45° field of view. Fundus photo — 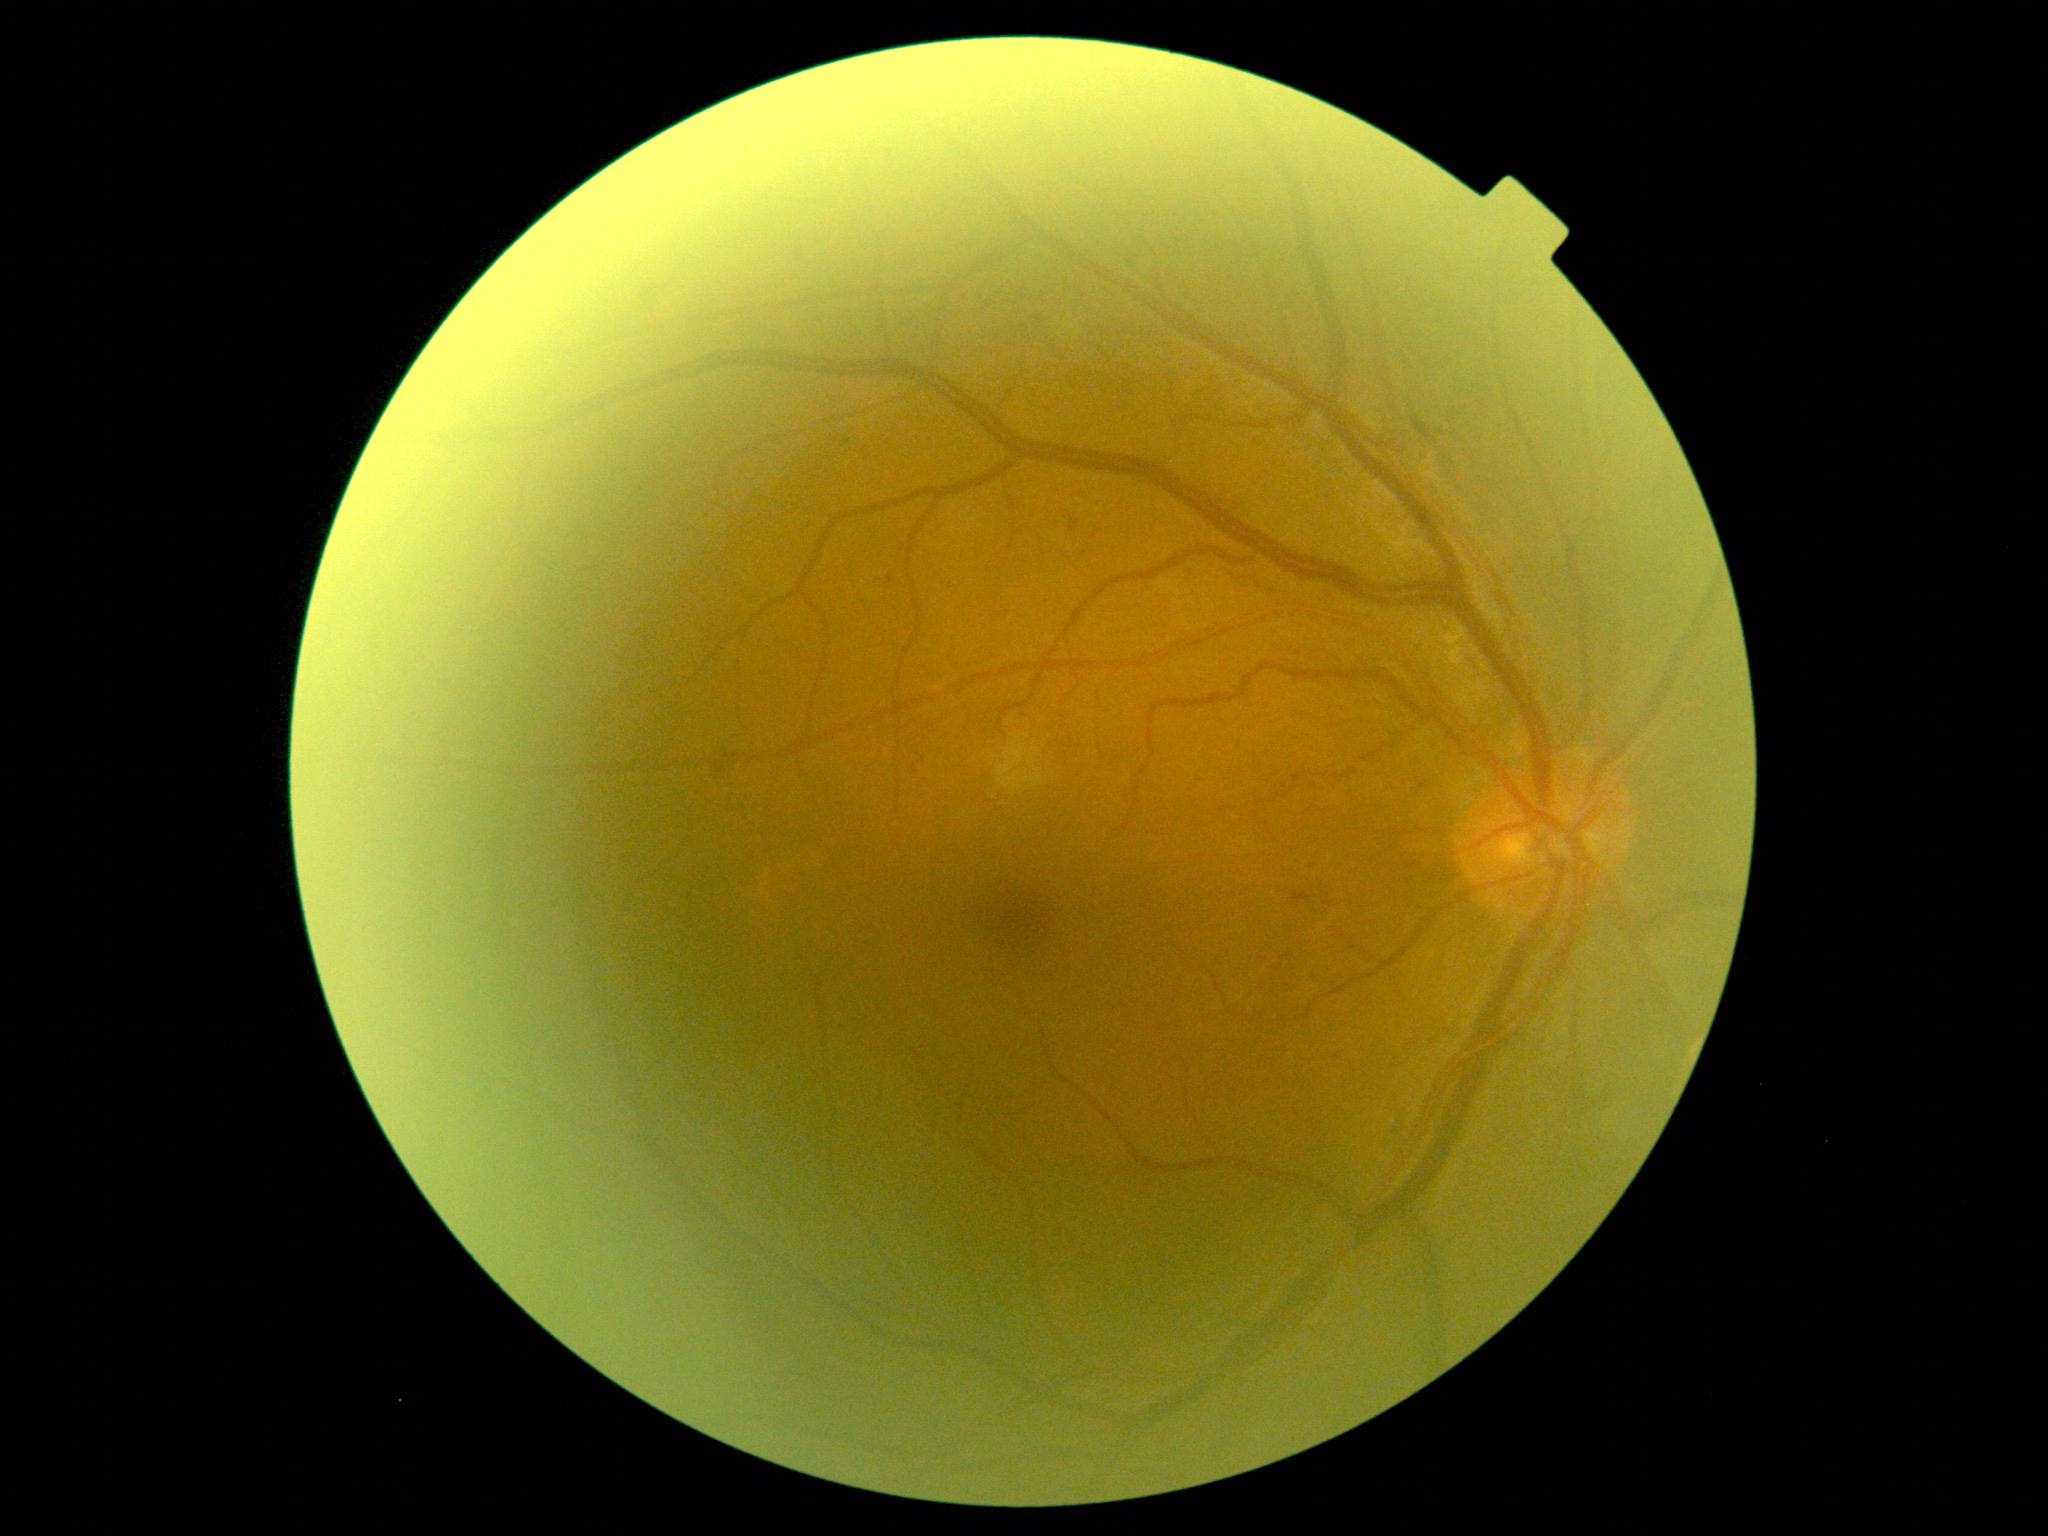 DR stage is moderate non-proliferative diabetic retinopathy (grade 2) — more than just microaneurysms but less than severe NPDR. The retinopathy is classified as non-proliferative diabetic retinopathy.